FOV: 45 degrees; 848x848px; NIDEK AFC-230 fundus camera; posterior pole color fundus photograph — 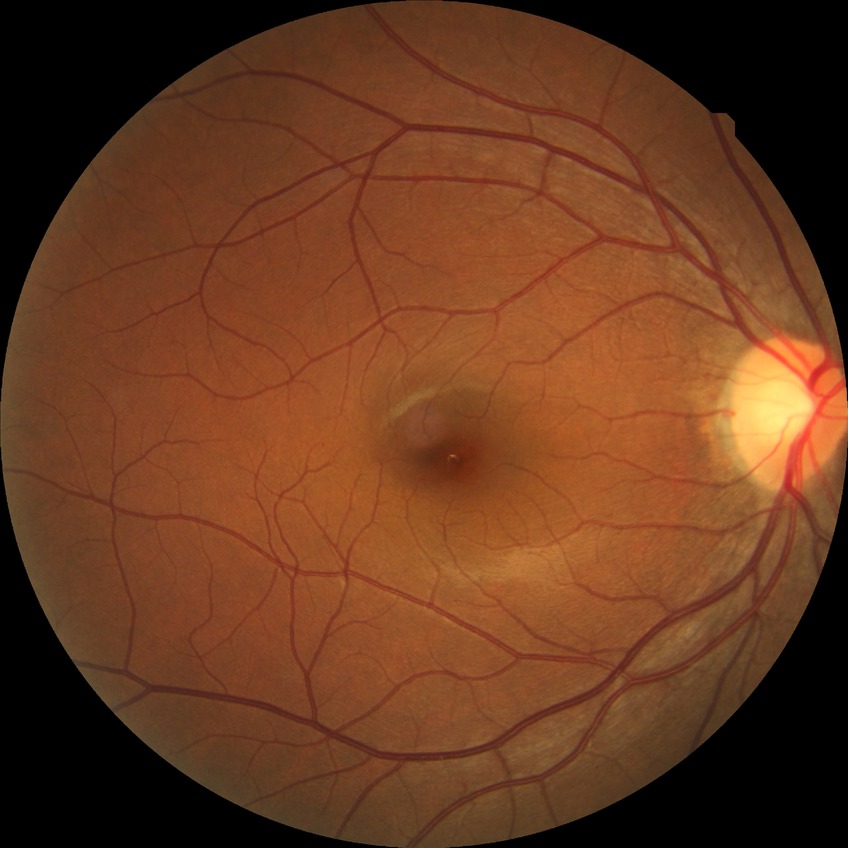

Diabetic retinopathy (DR) is NDR (no diabetic retinopathy).